FOV: 45 degrees, color fundus photograph — 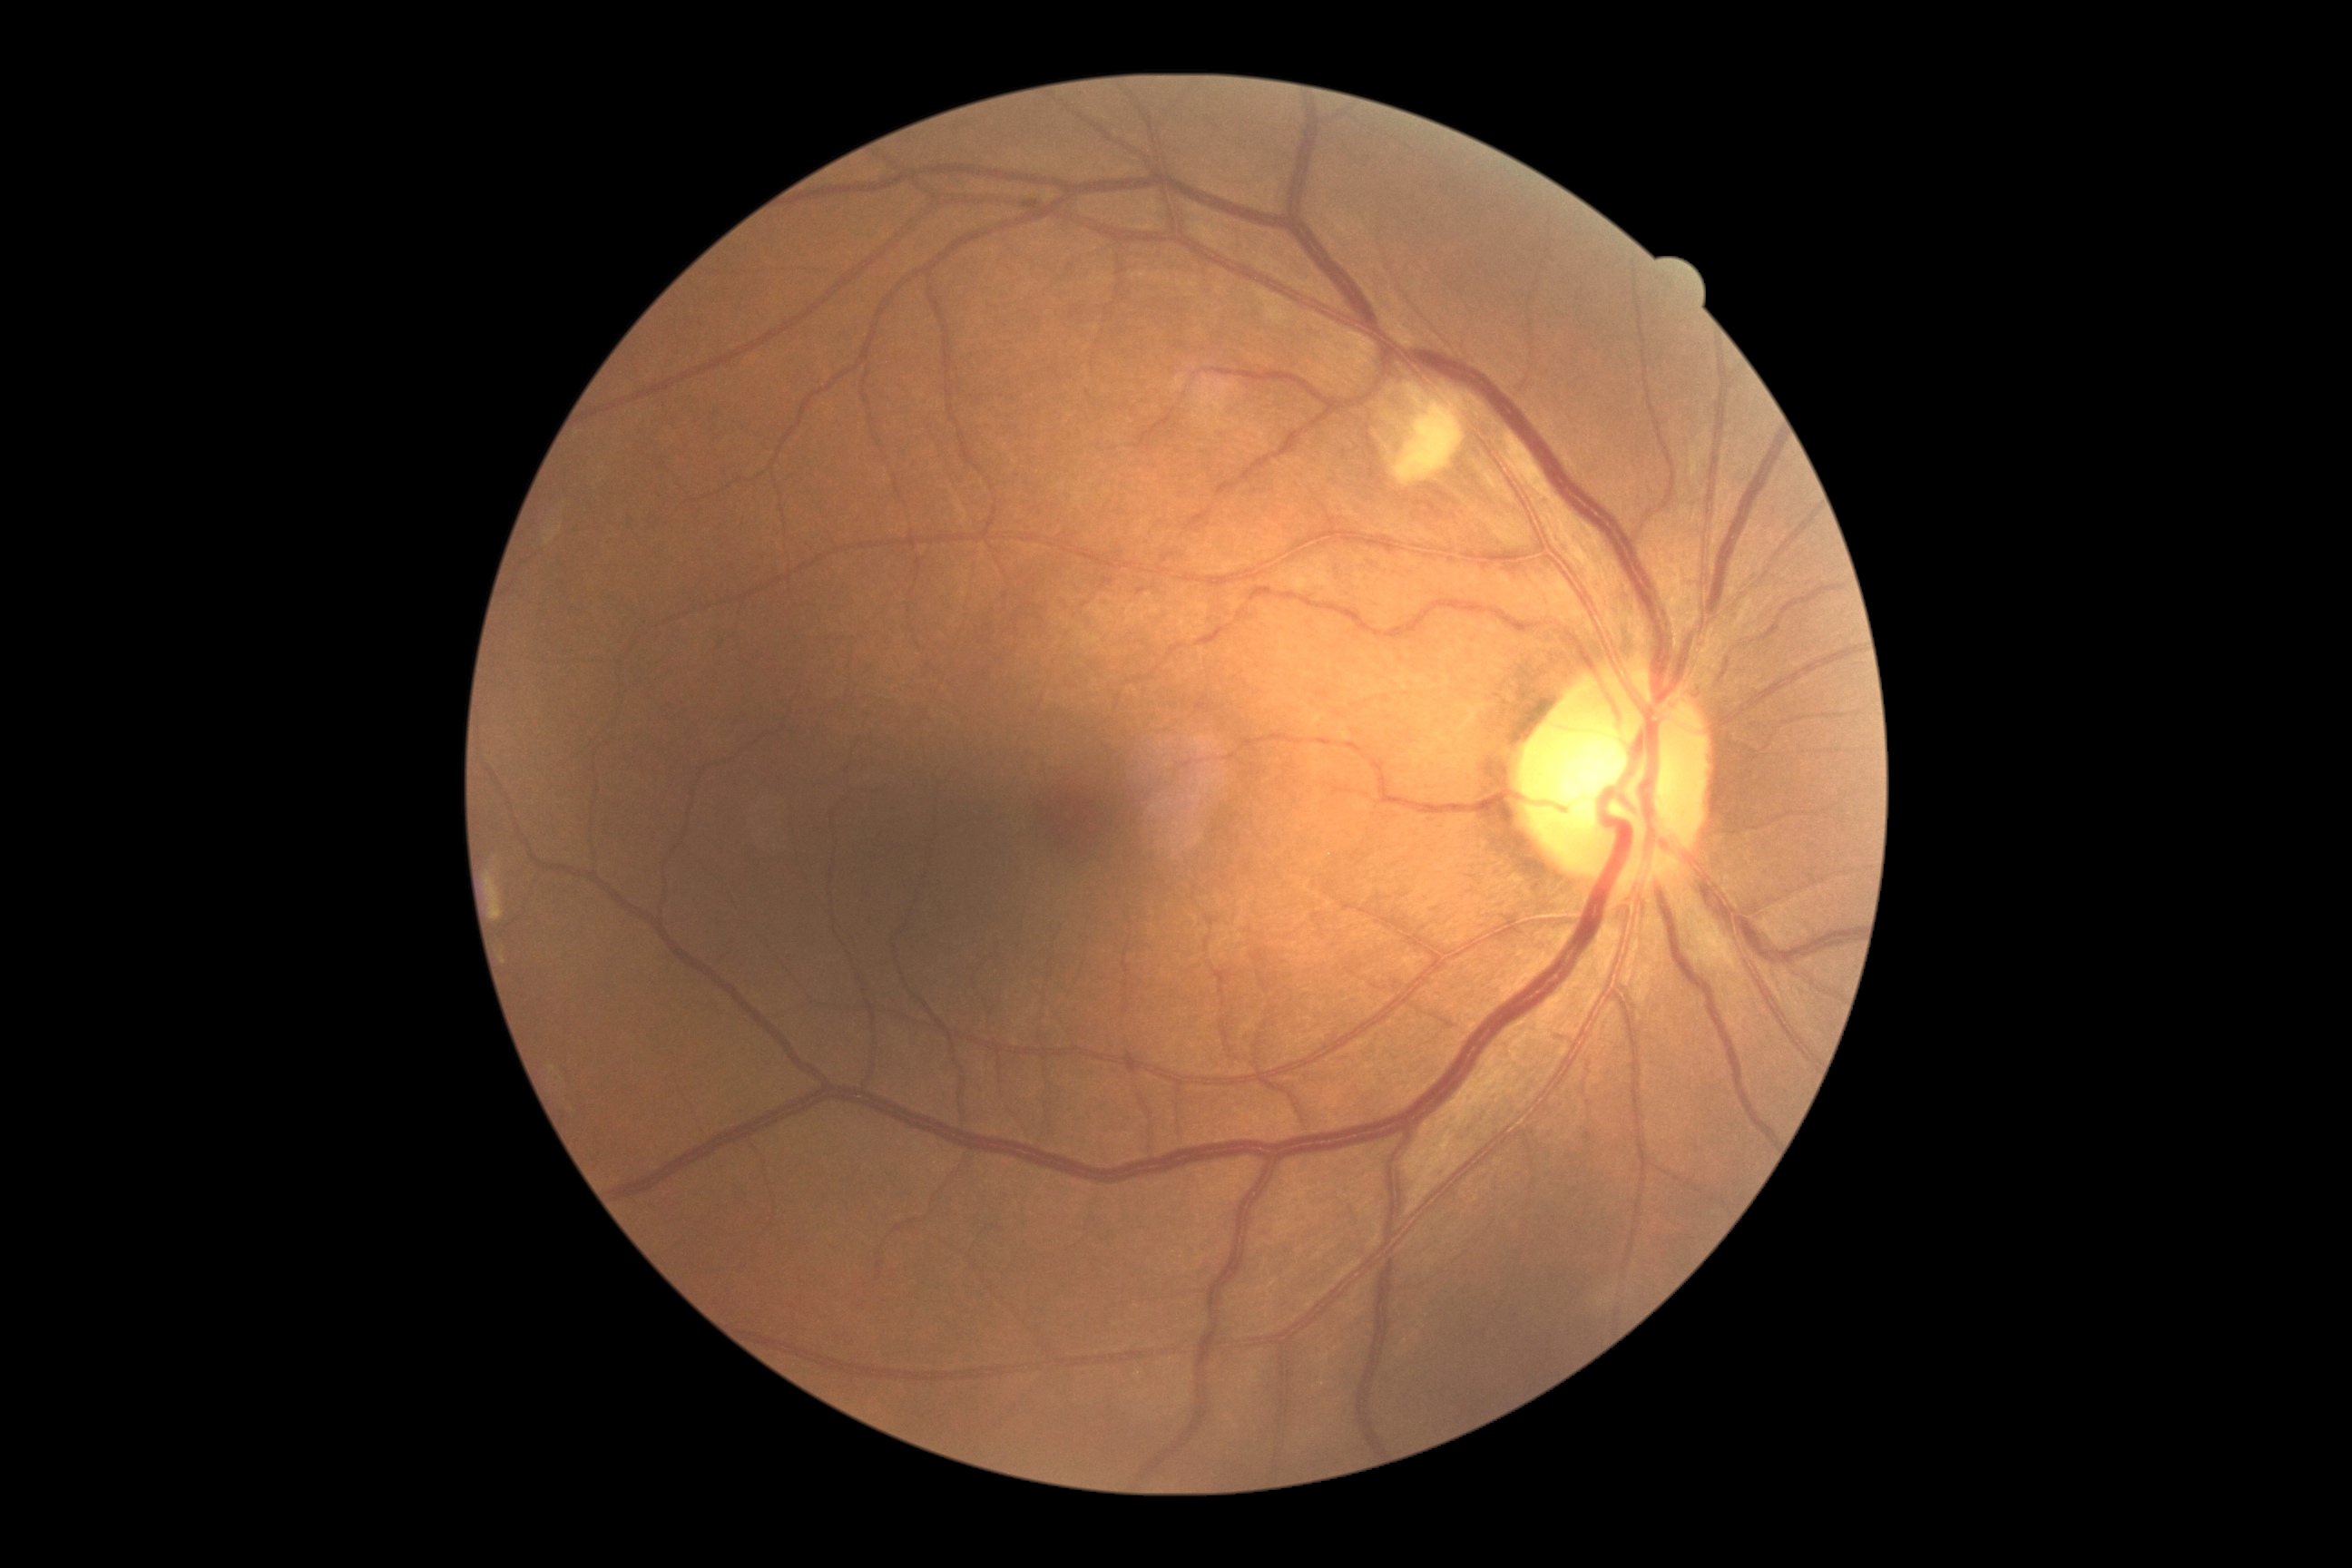

Diabetic retinopathy grade is 2 (moderate NPDR). Disease class: non-proliferative diabetic retinopathy.